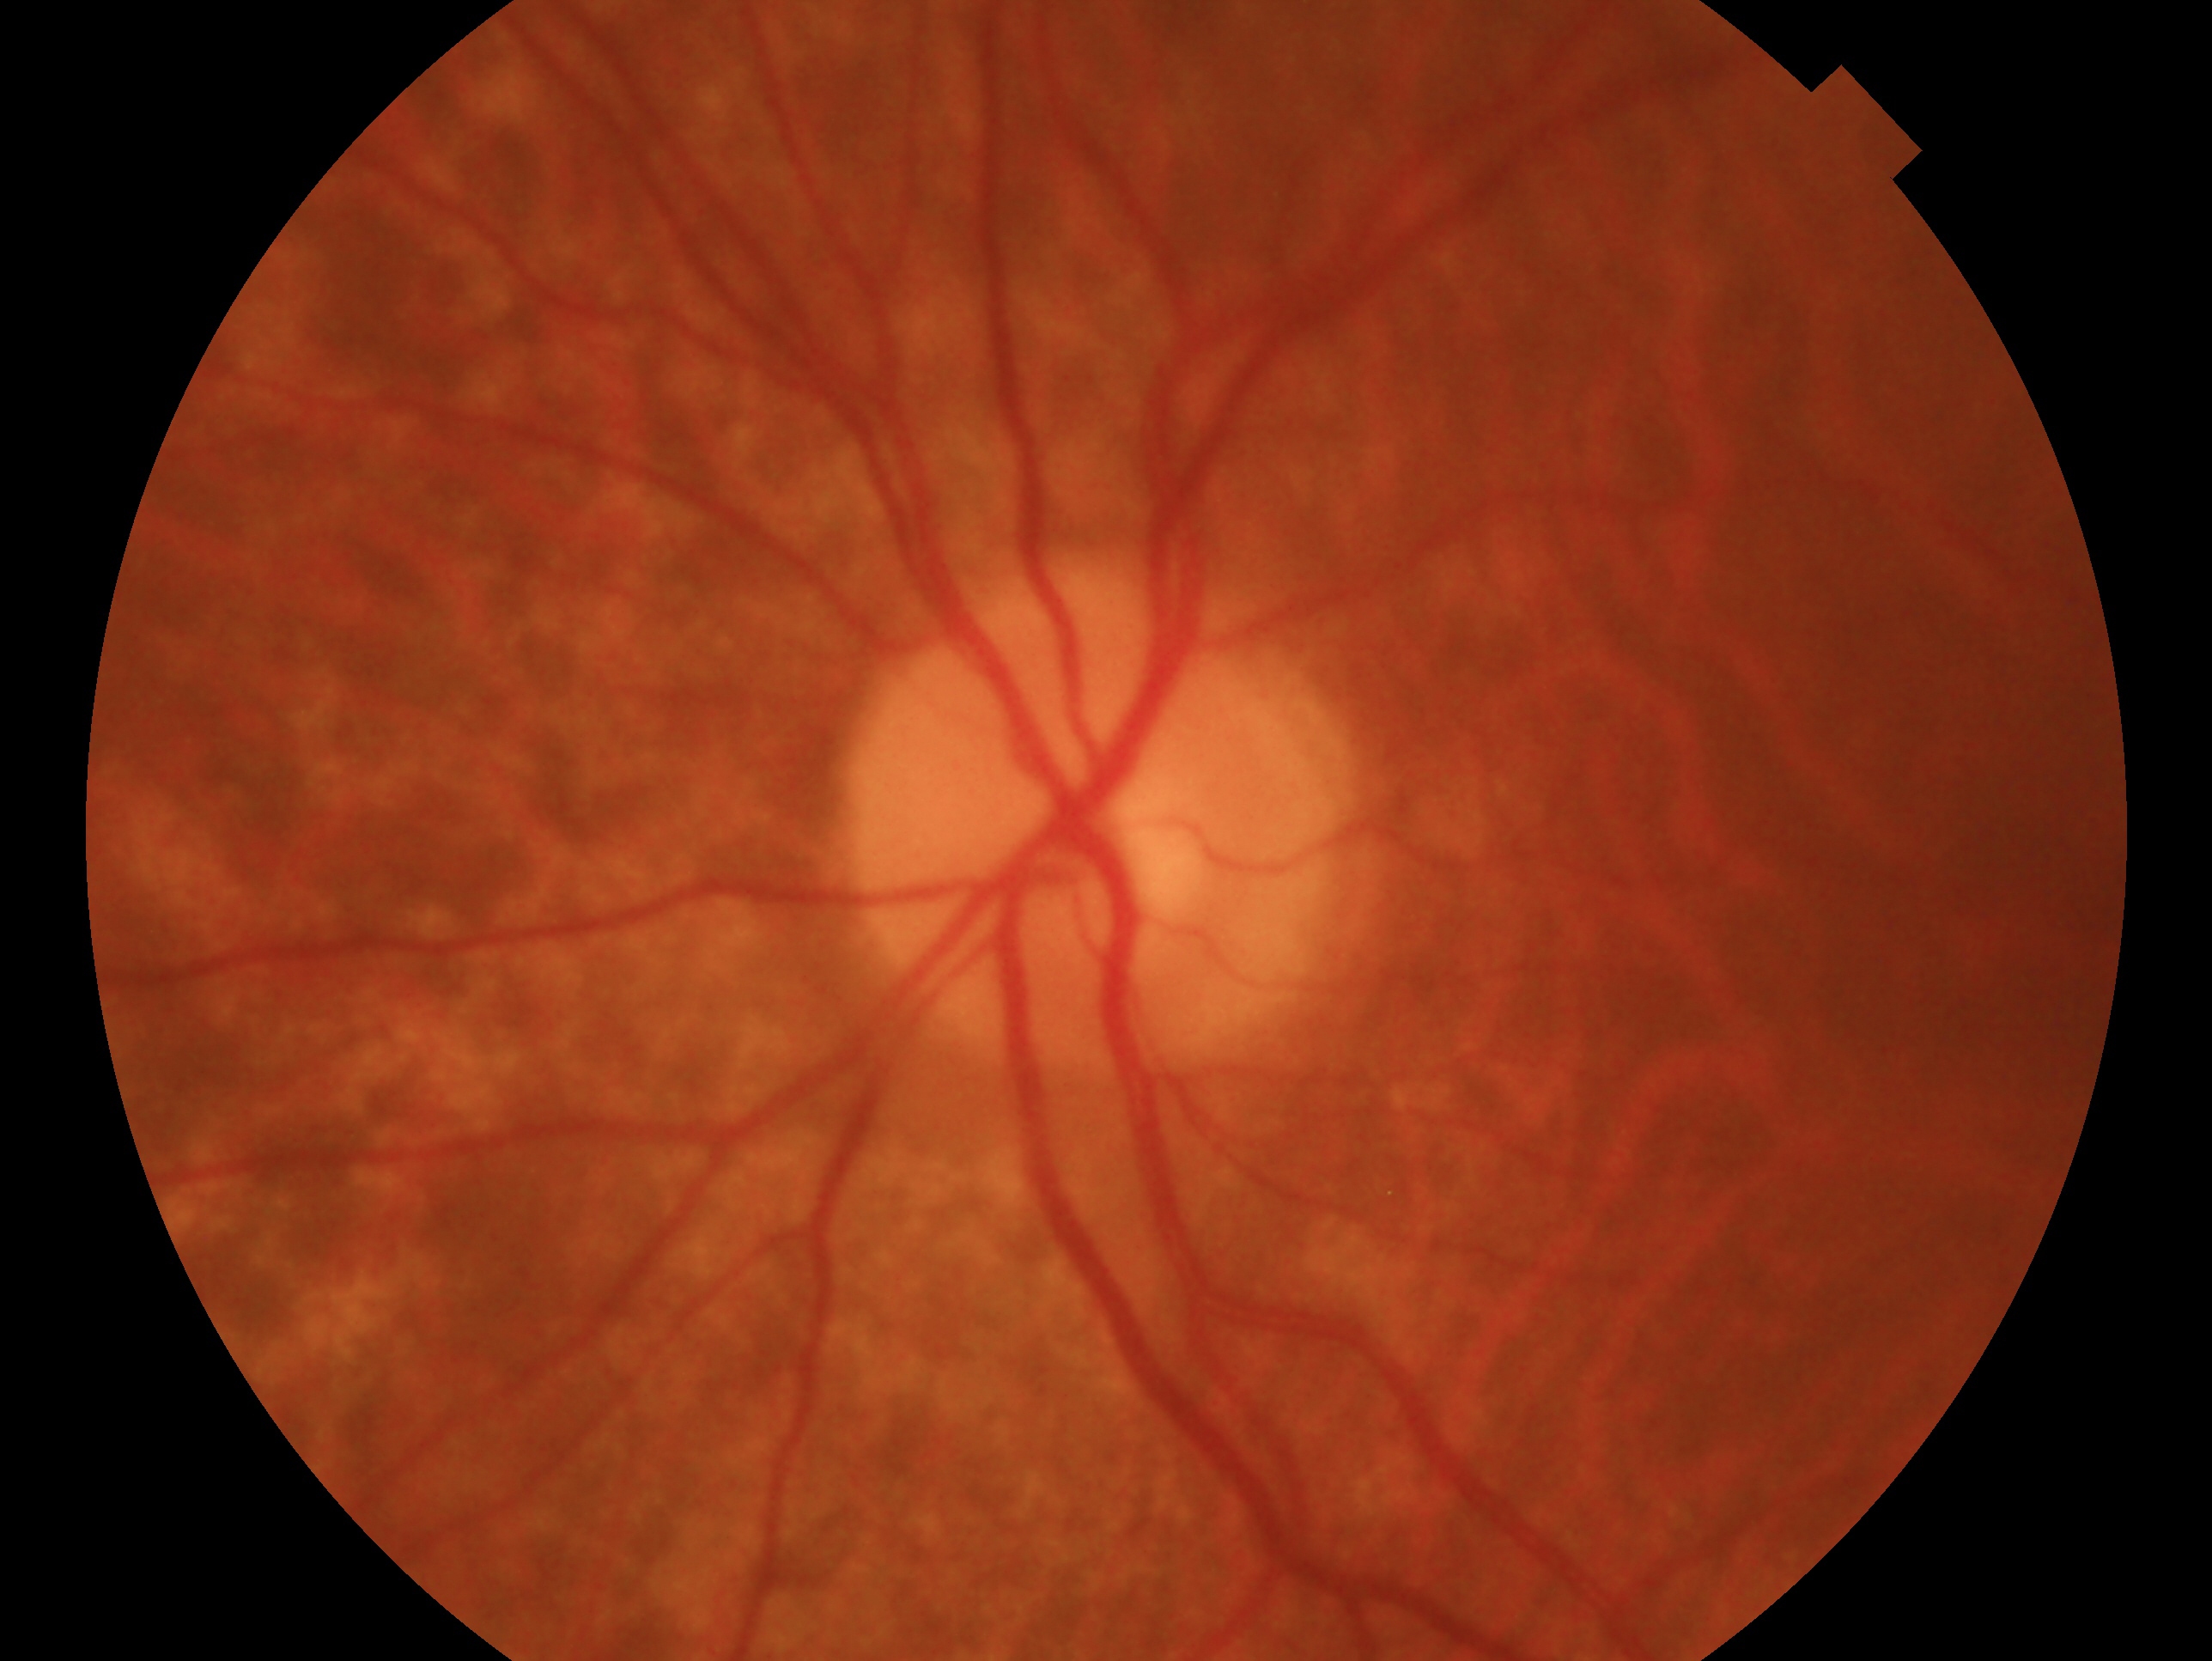
laterality: oculus sinister, clinical classification: no evidence of glaucoma.